Posterior pole color fundus photograph. 848 by 848 pixels — 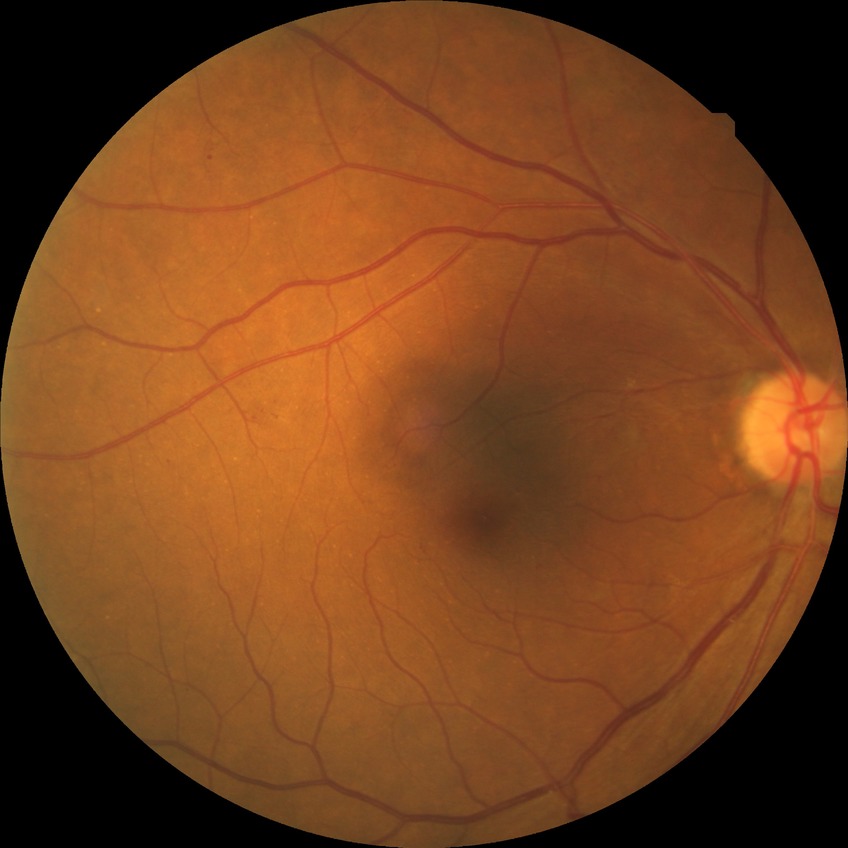
diabetic retinopathy (DR)@simple diabetic retinopathy (SDR).